FOV: 45 degrees, 2352 by 1568 pixels, CFP — 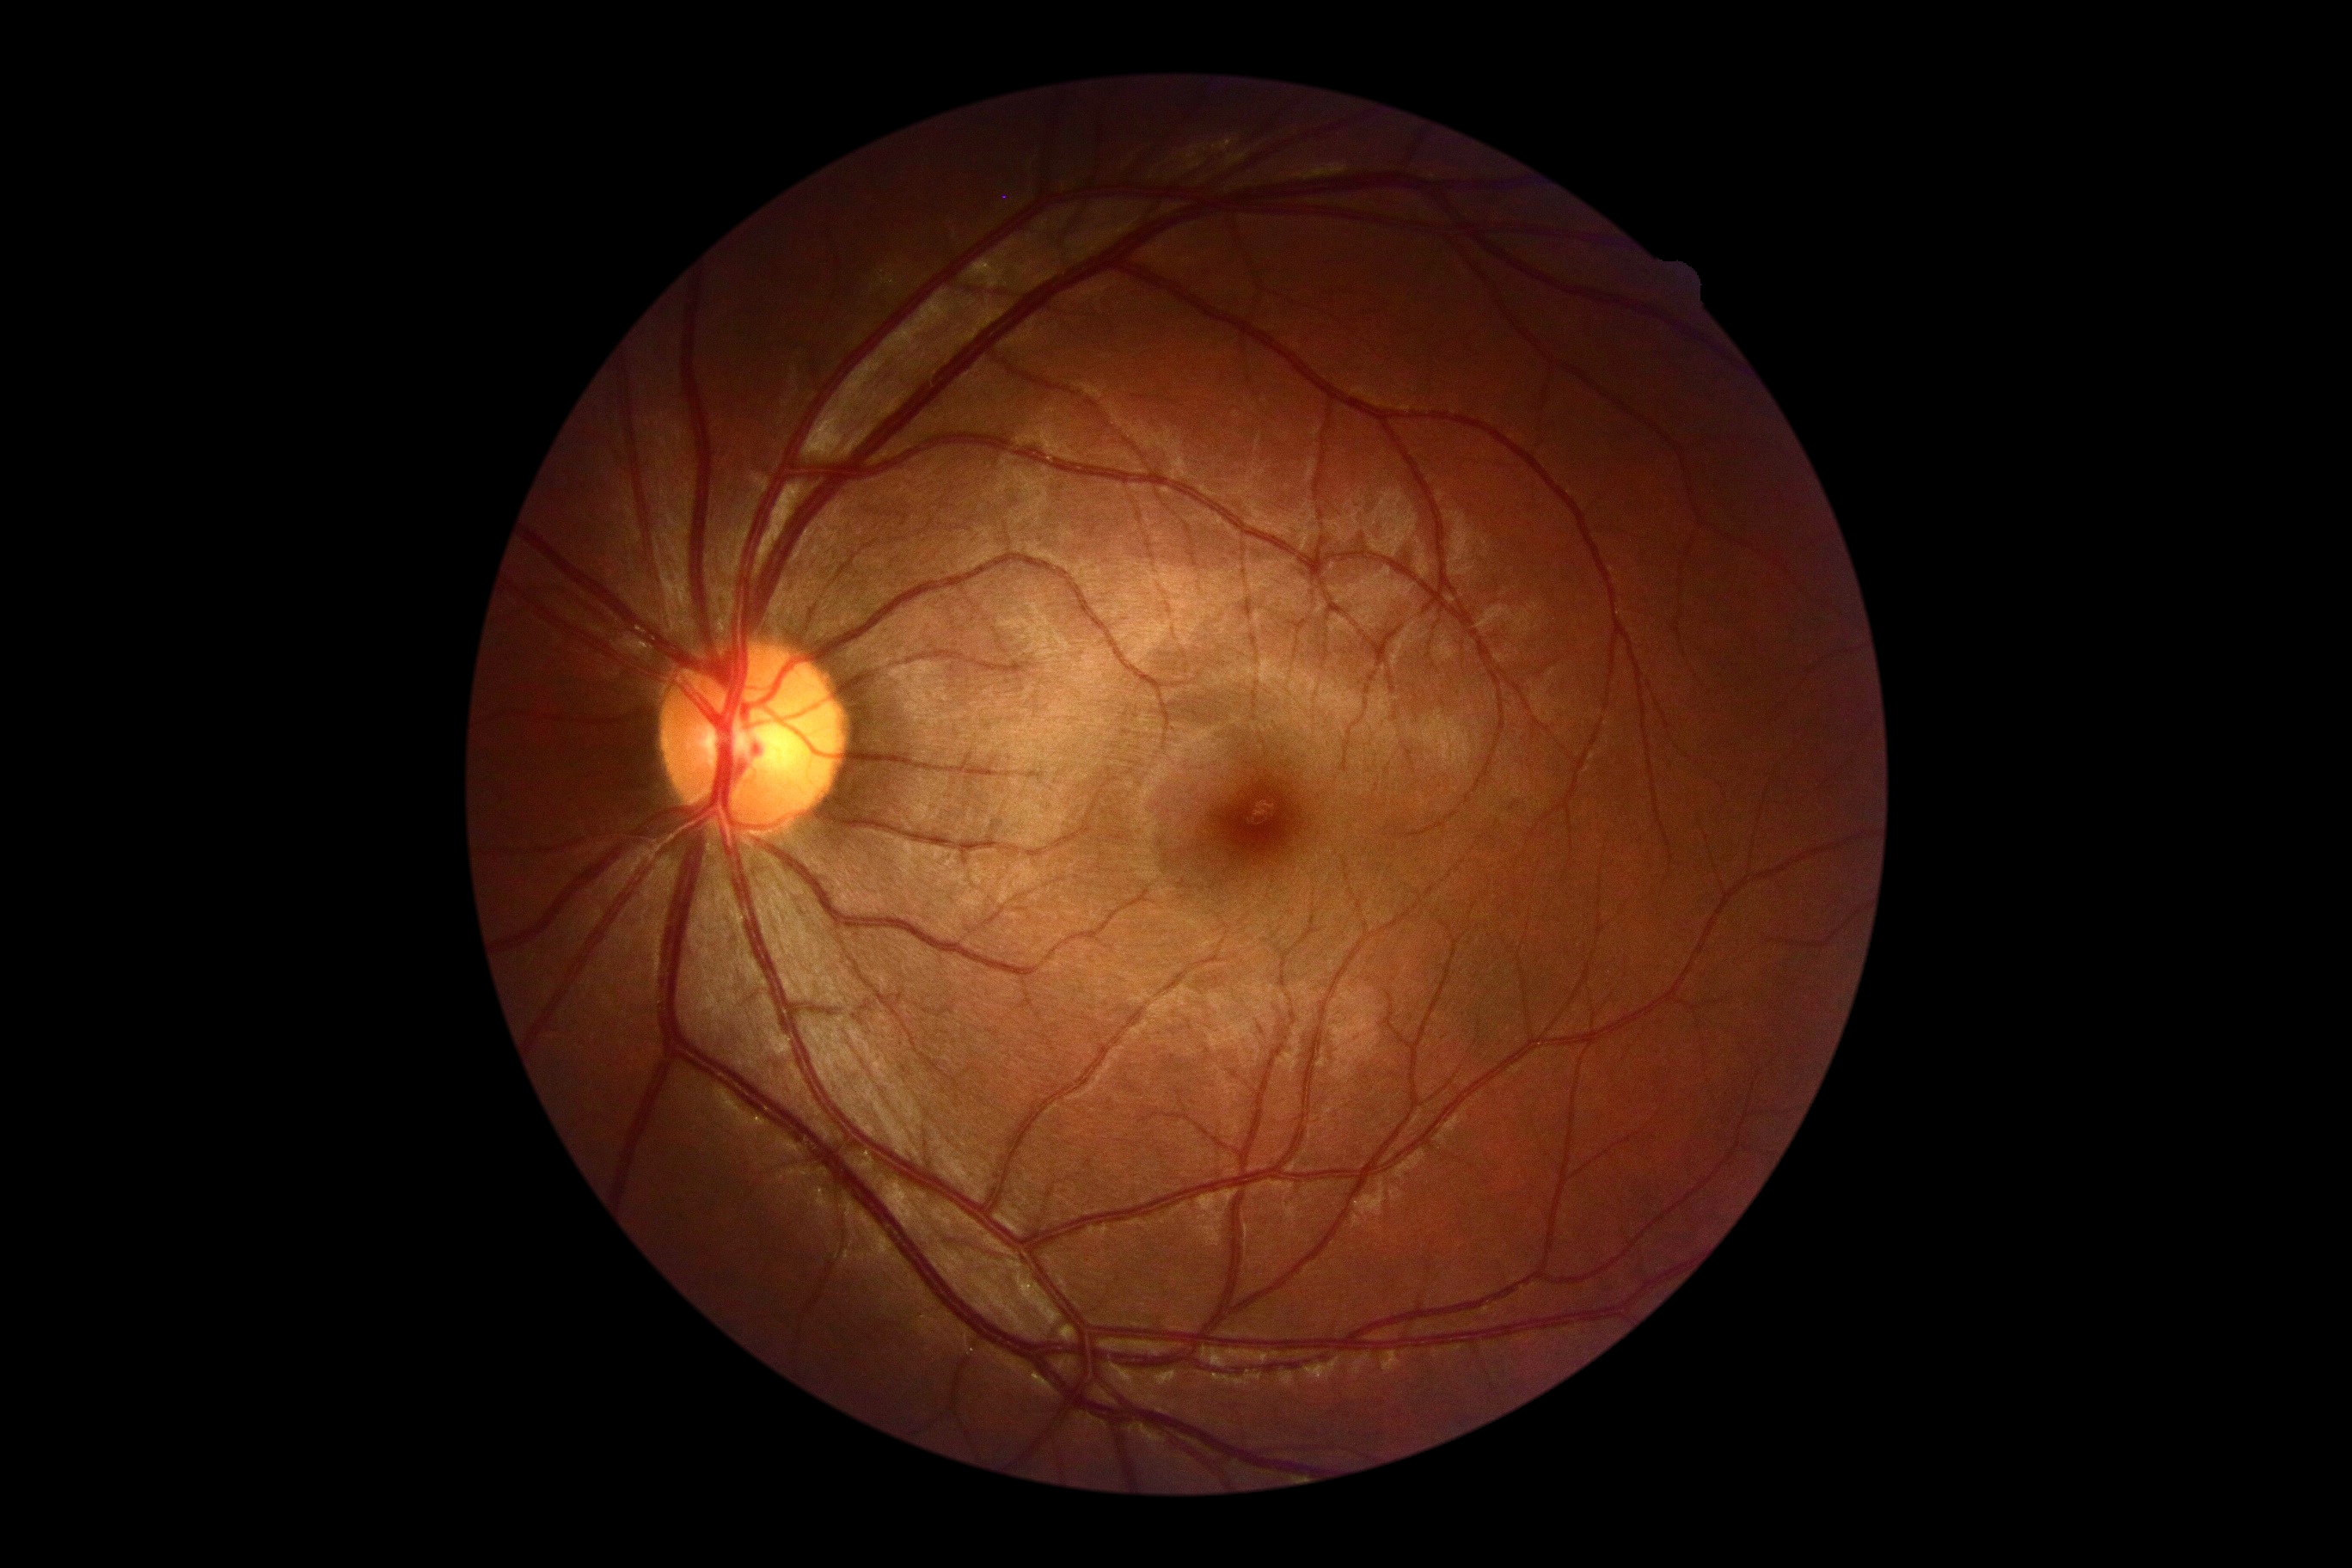 {
  "dr_grade": "0"
}